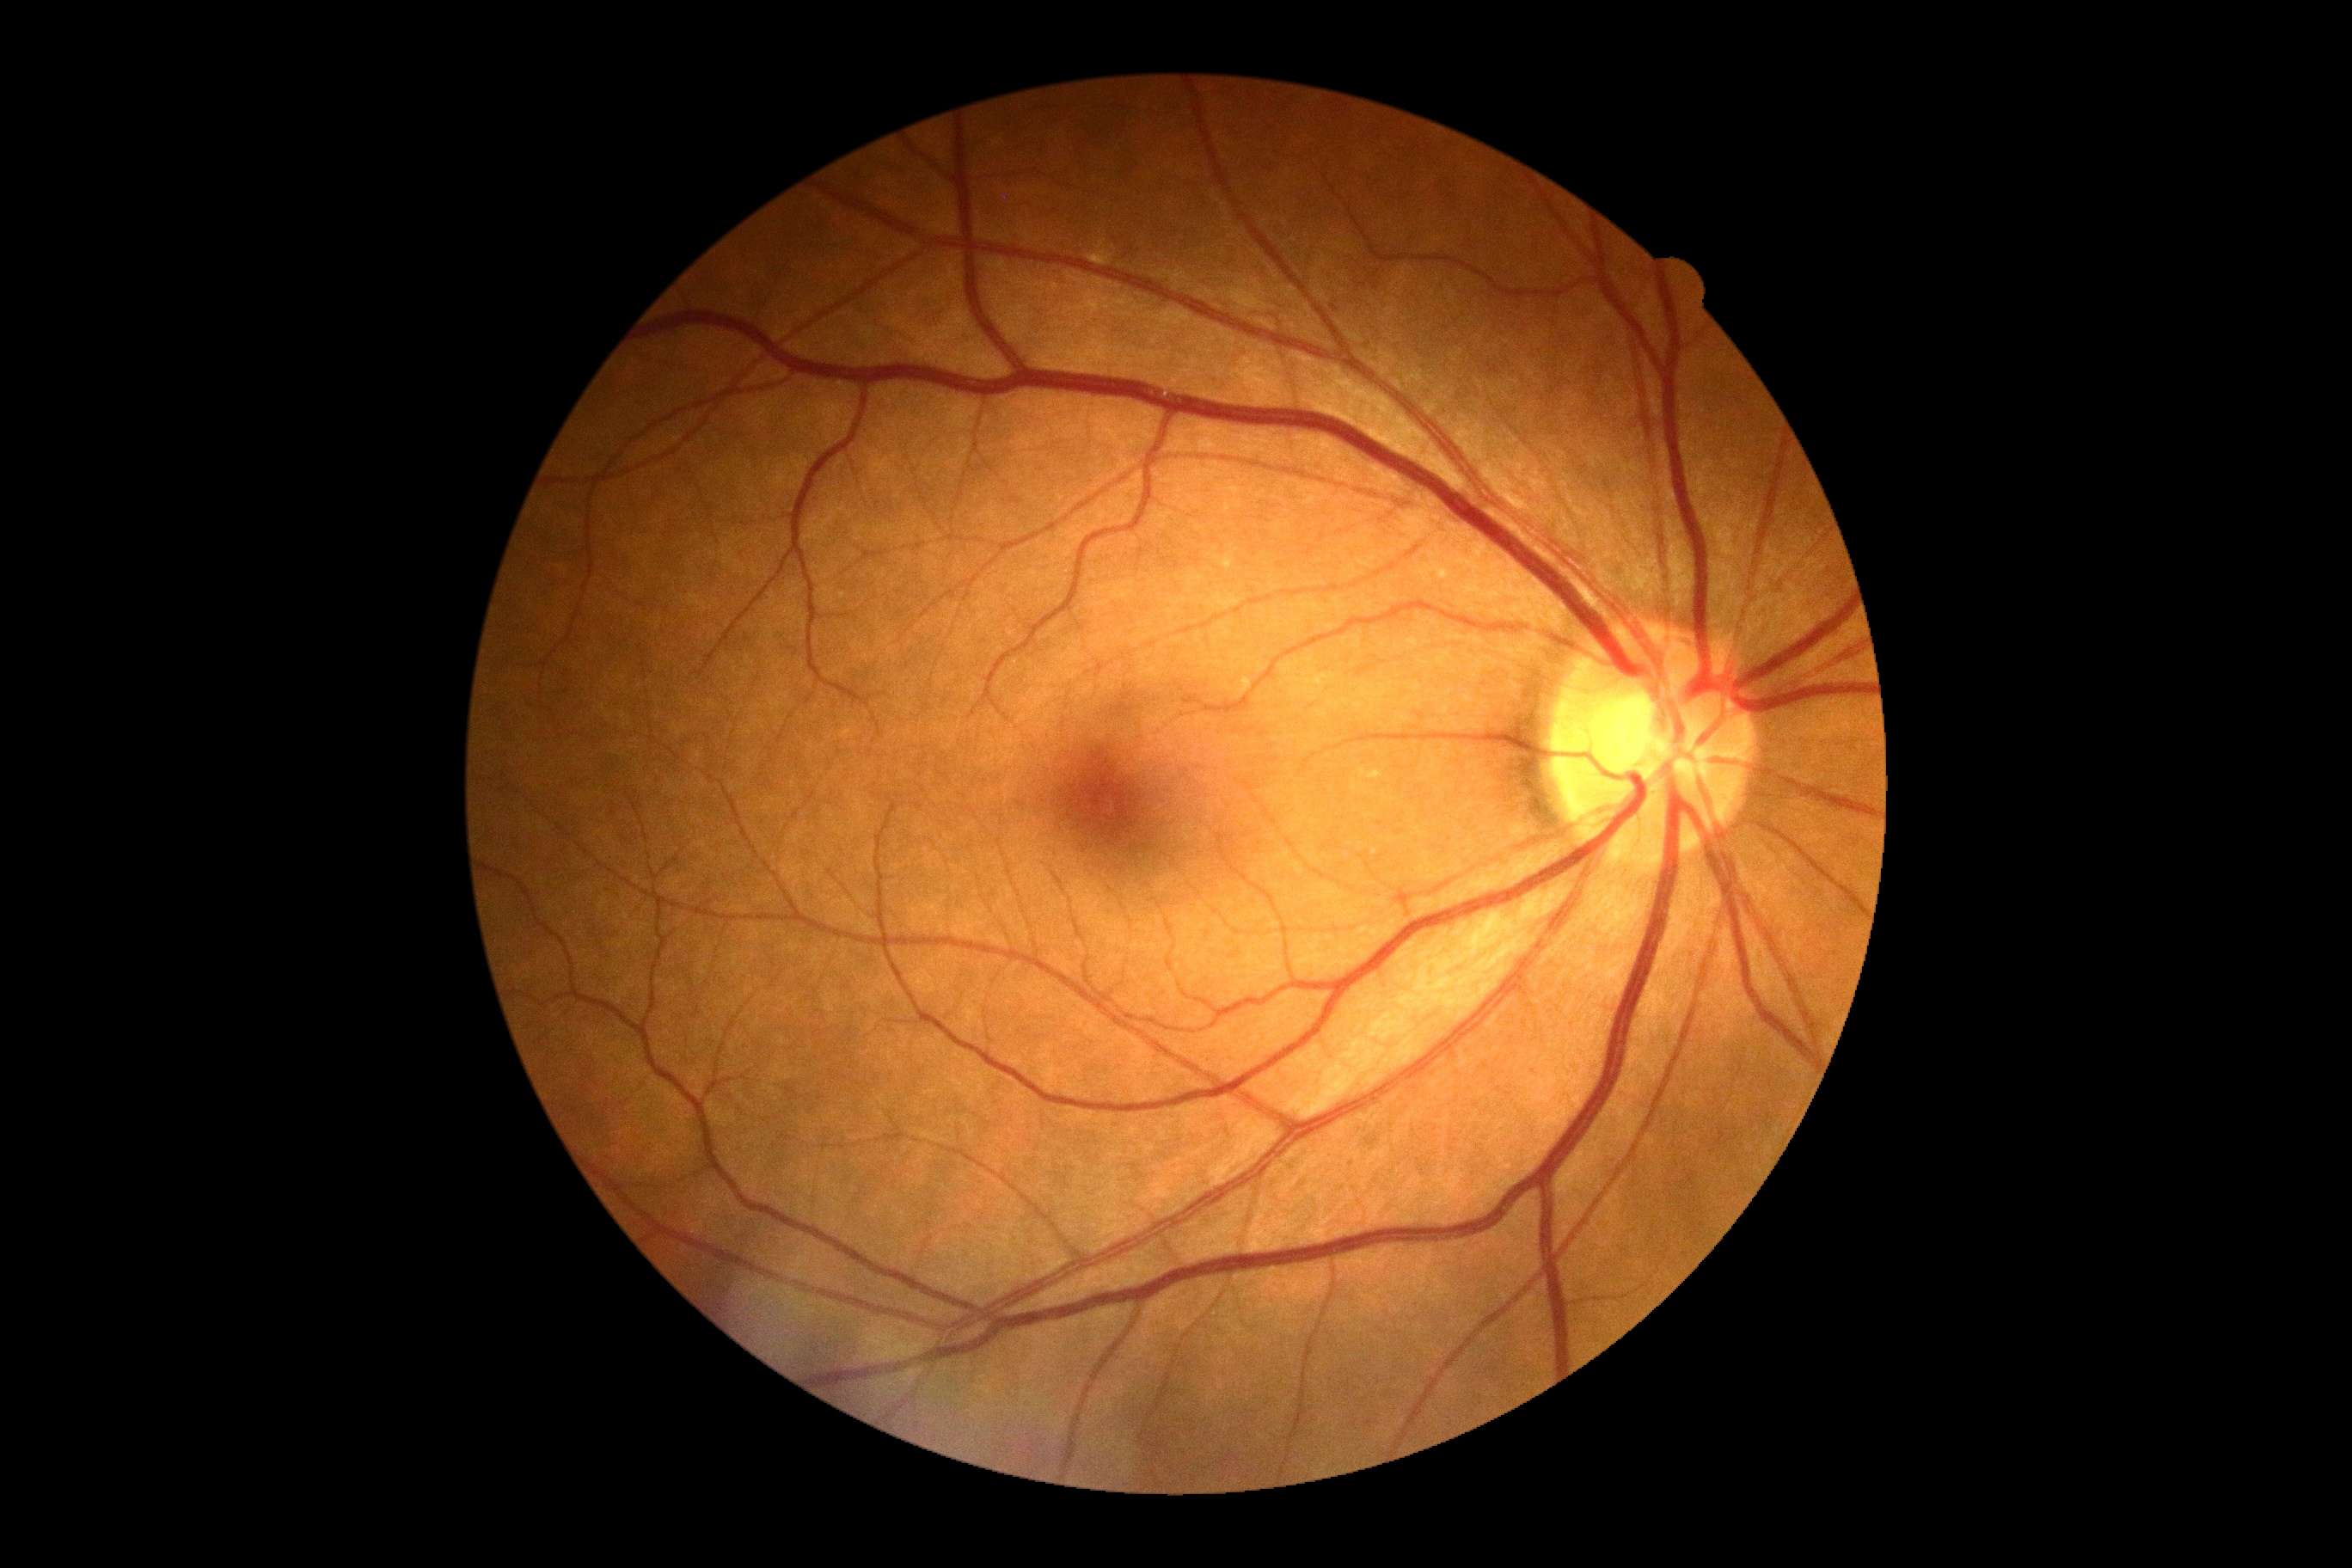 DR severity: no apparent diabetic retinopathy (grade 0).